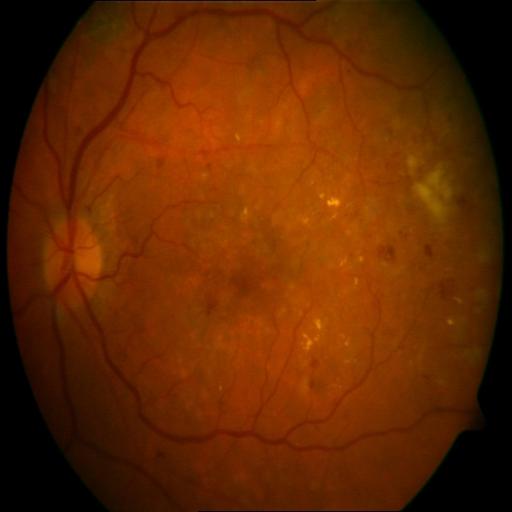 Findings:
- exudation
- cotton wool spots
- hemorrhagic retinopathy